CFP:
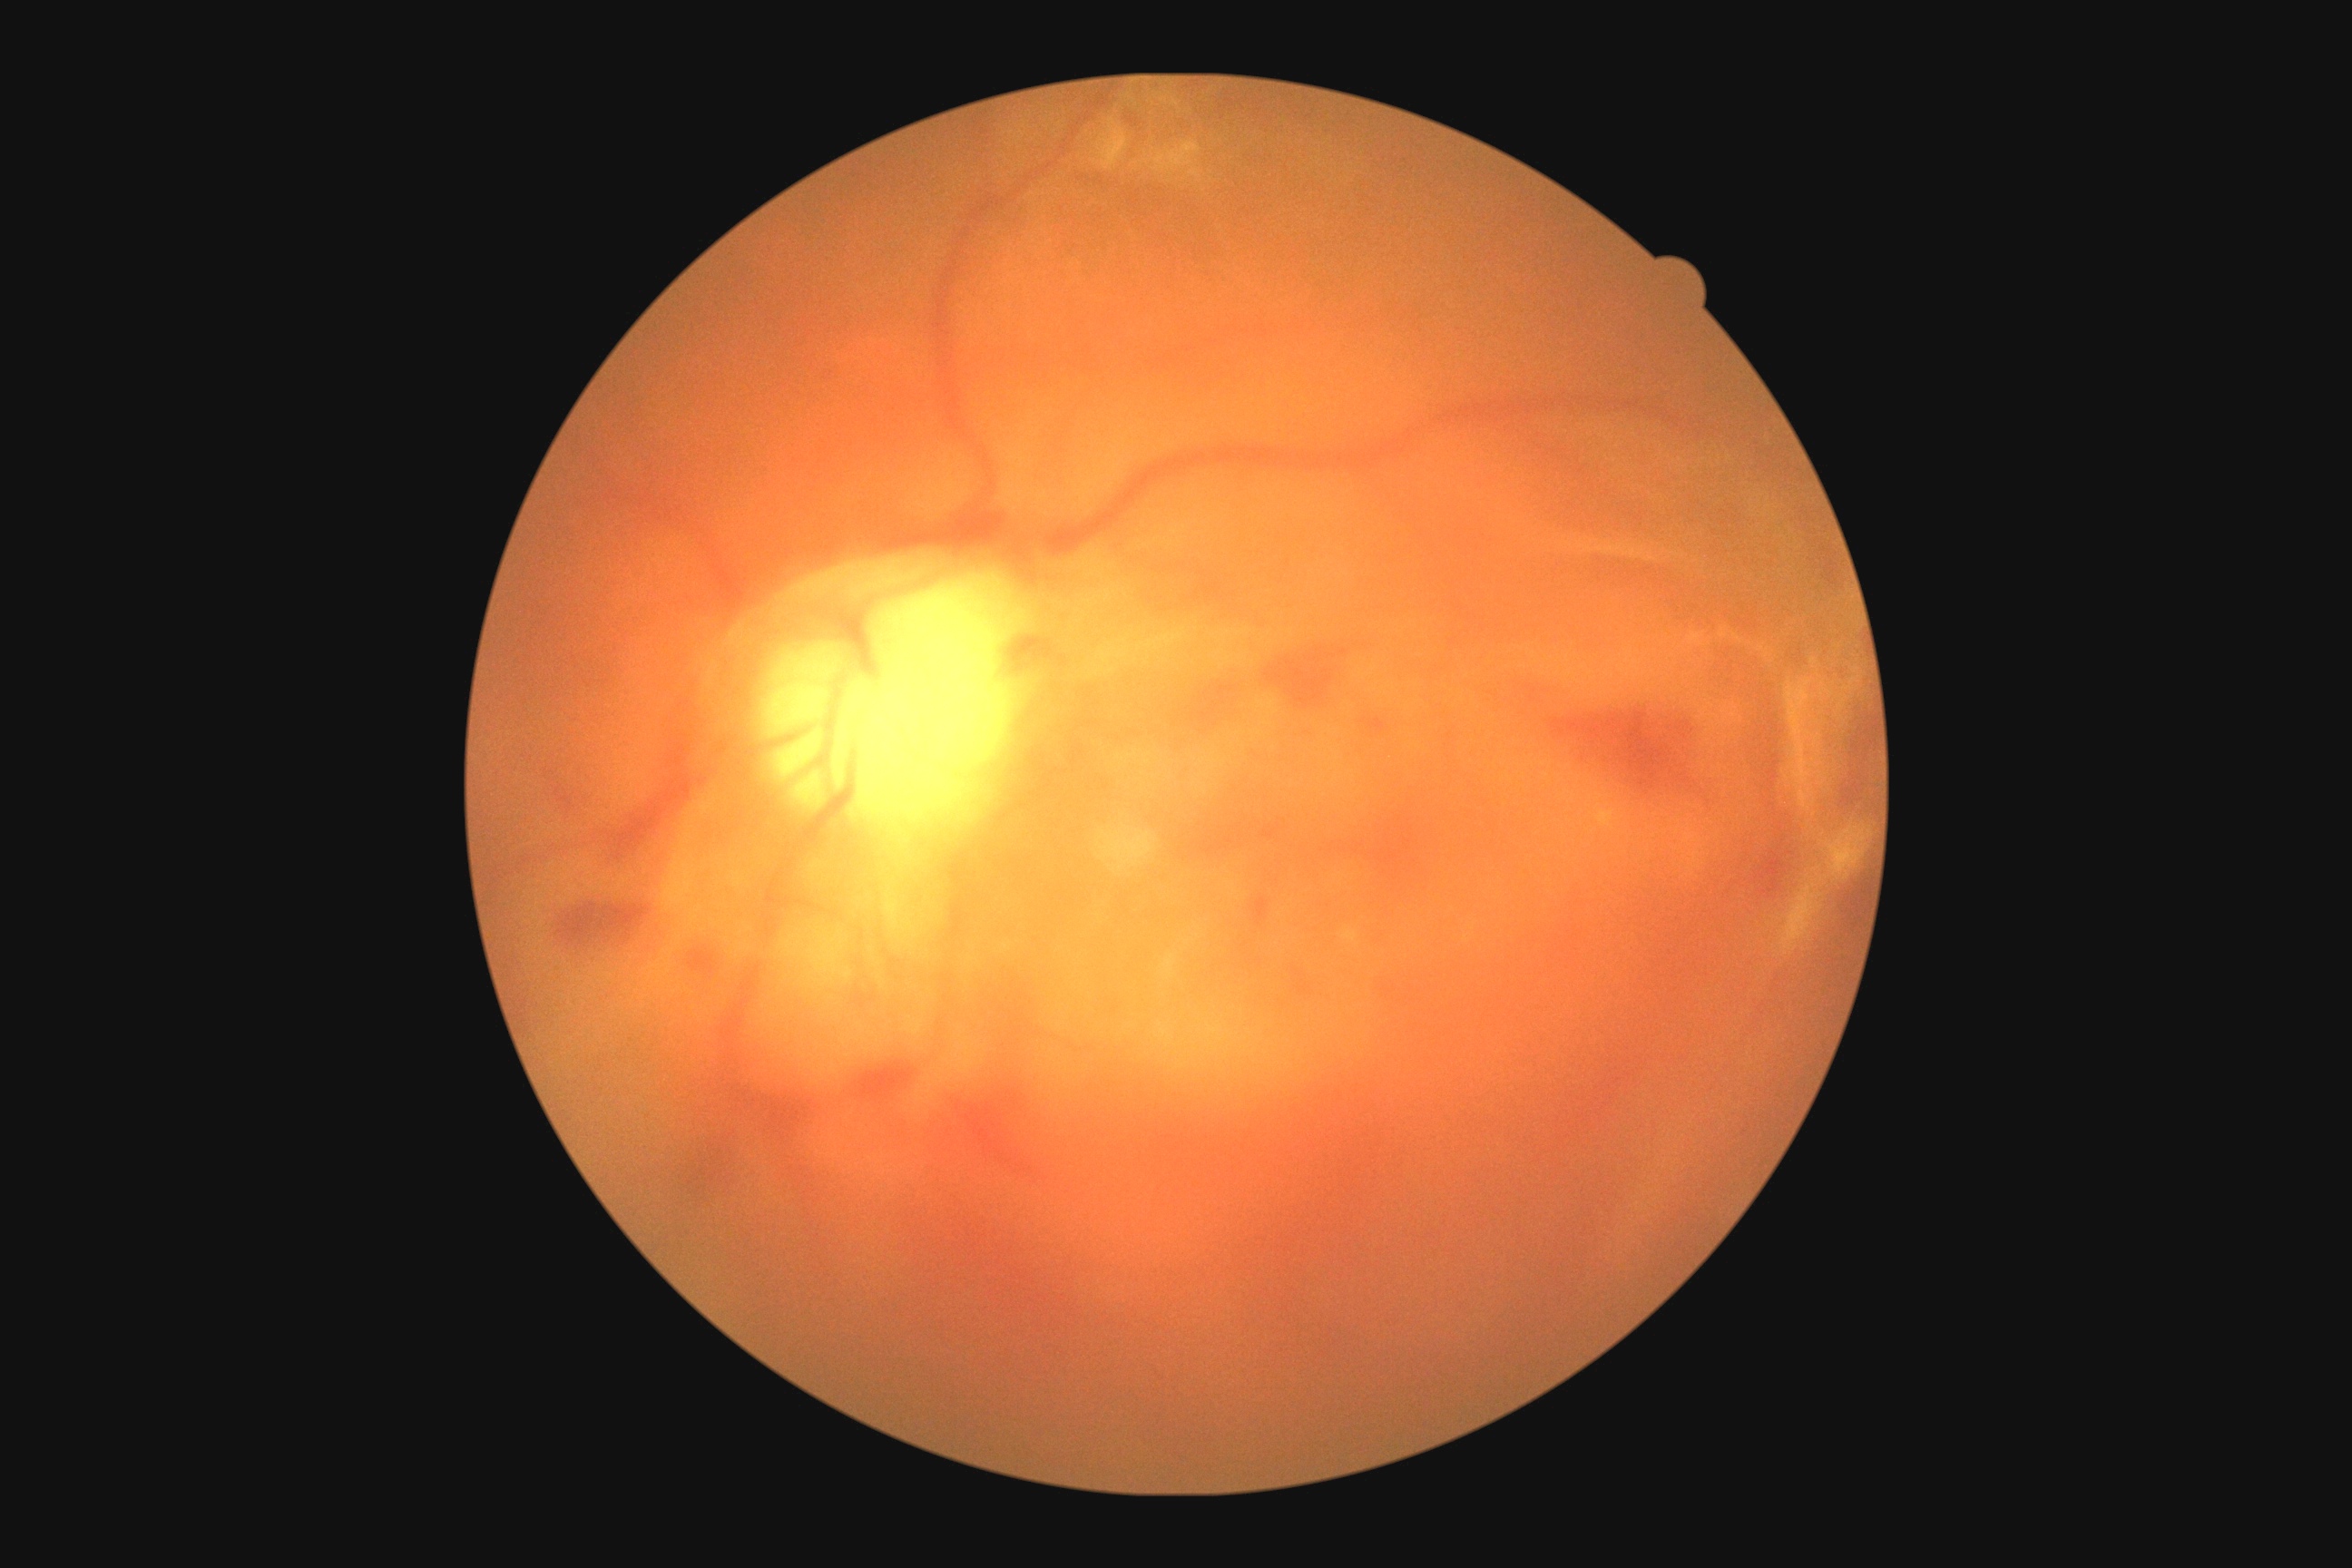 diabetic retinopathy grade: 4.